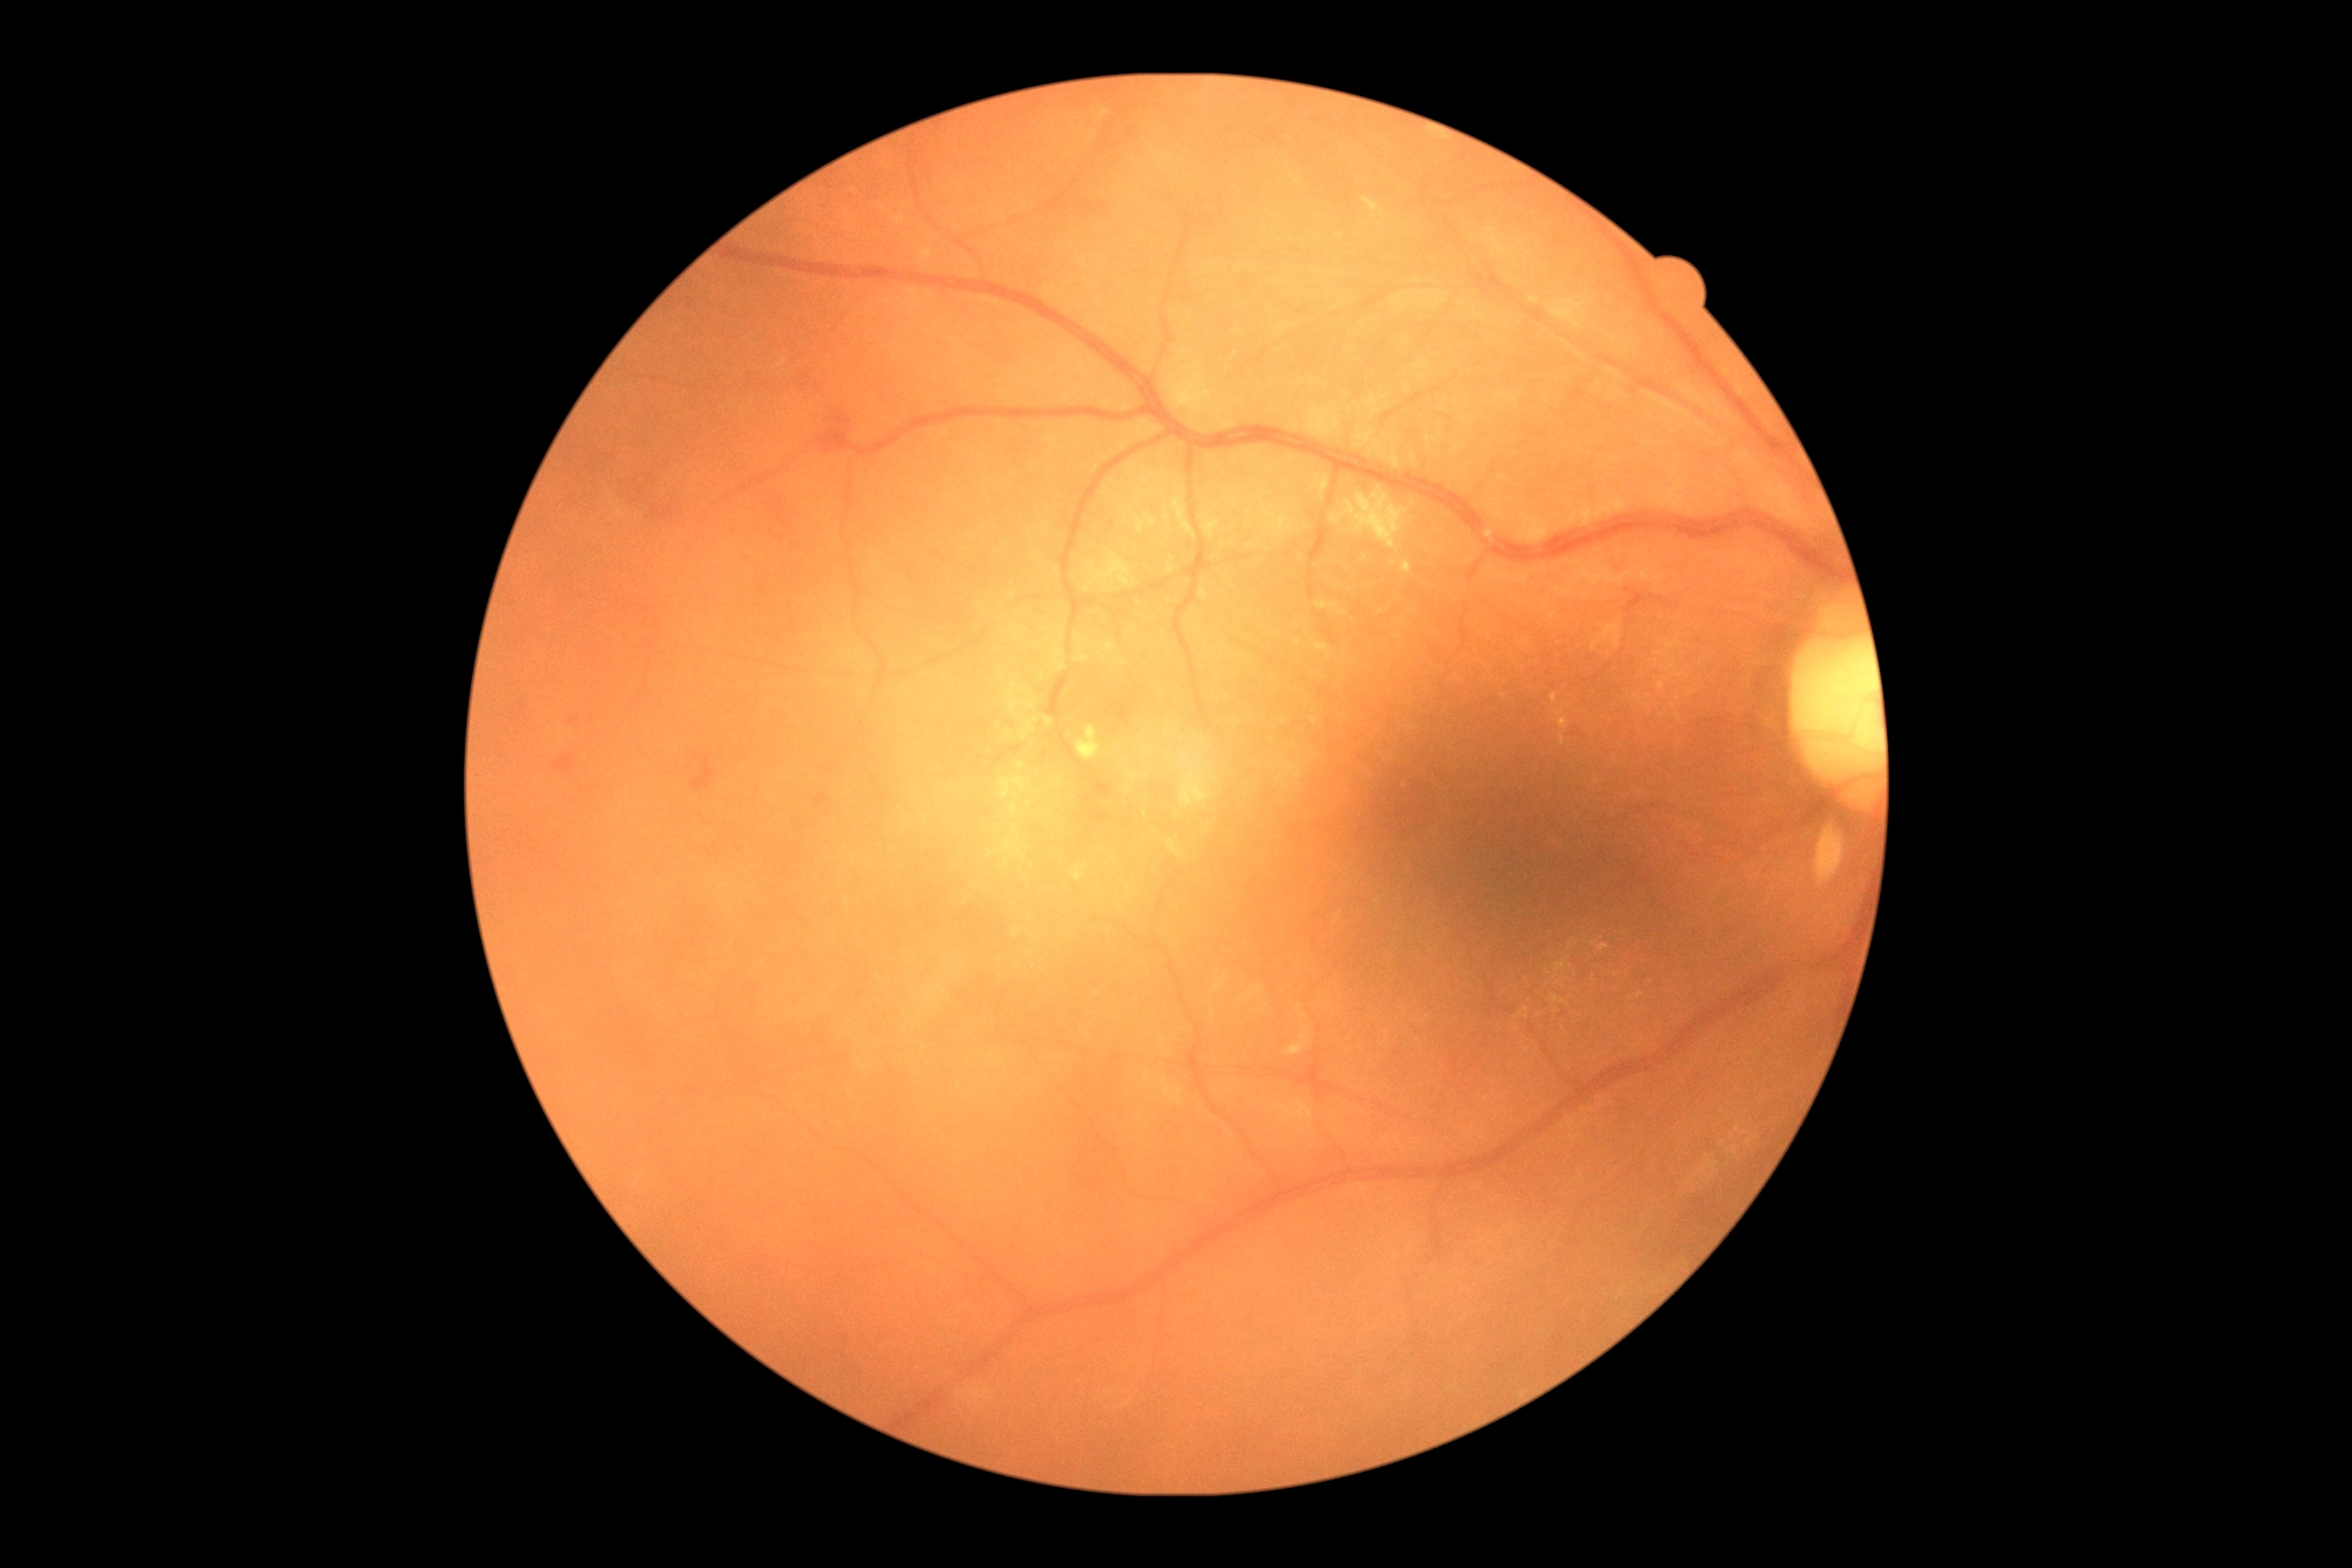

  dr_grade: moderate non-proliferative diabetic retinopathy (grade 2)
  dr_category: non-proliferative diabetic retinopathy